Infant wide-field retinal image. 1240x1240
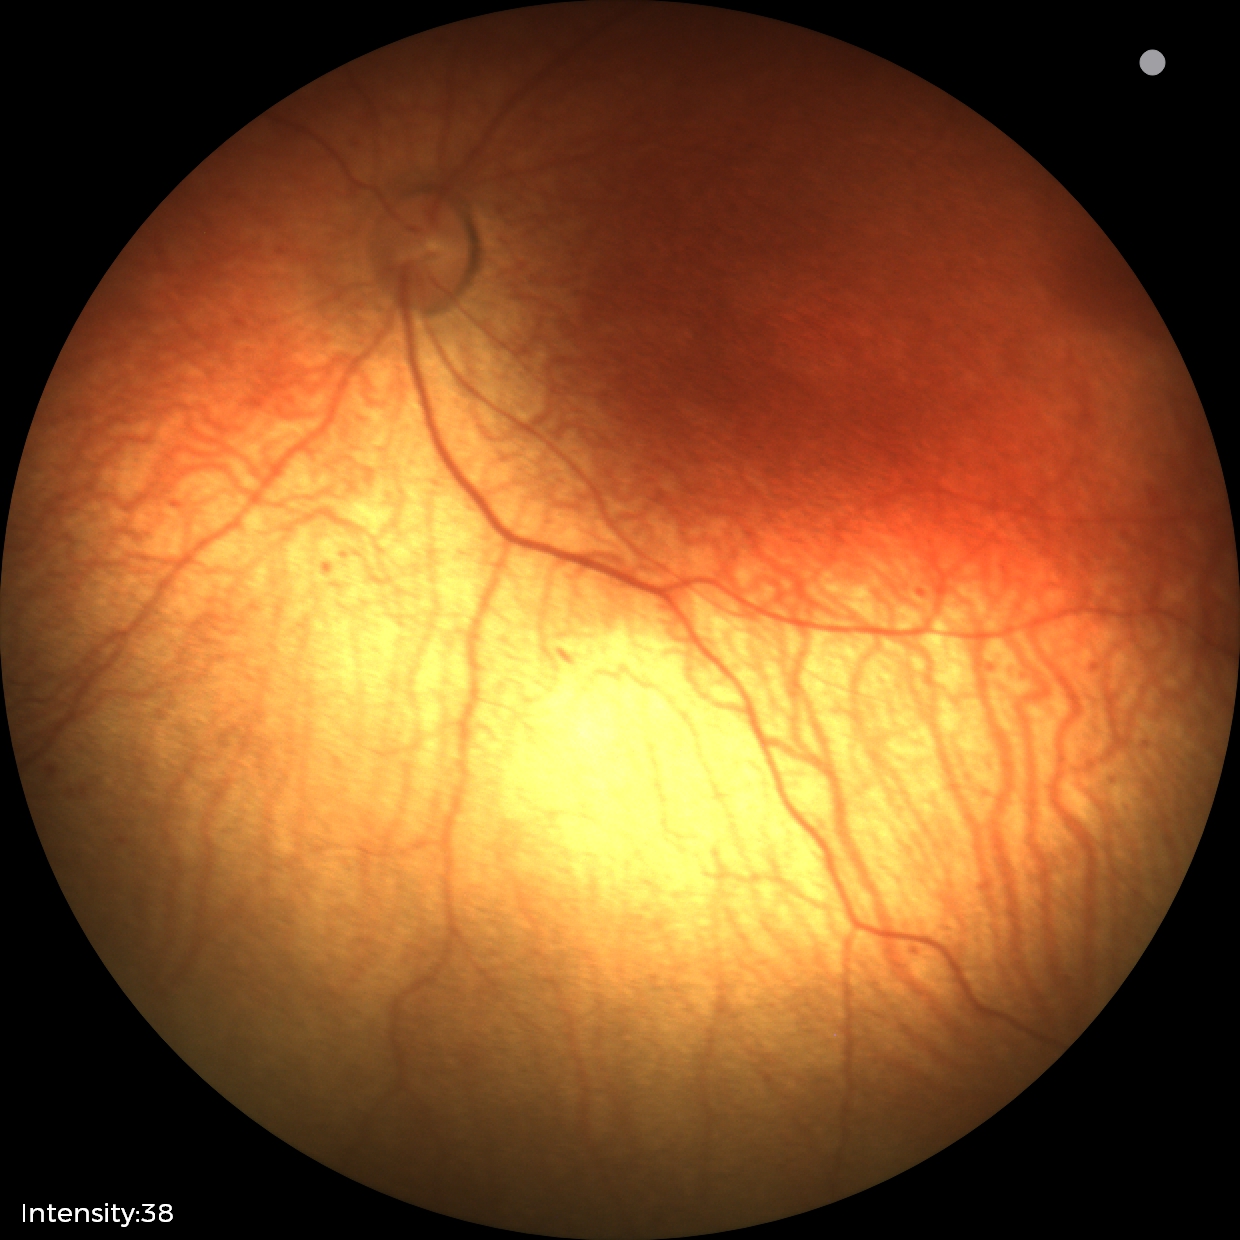
Plus disease: absent
screening diagnosis: status post ROP